848x848 · no pharmacologic dilation: 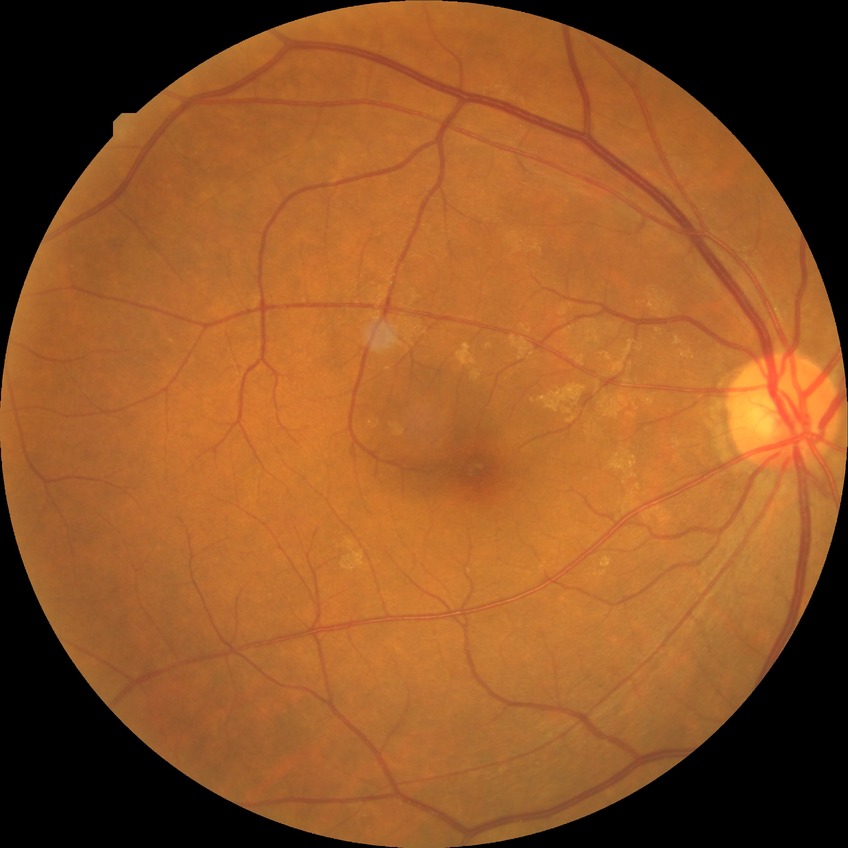

Findings:
- modified Davis grading: no diabetic retinopathy